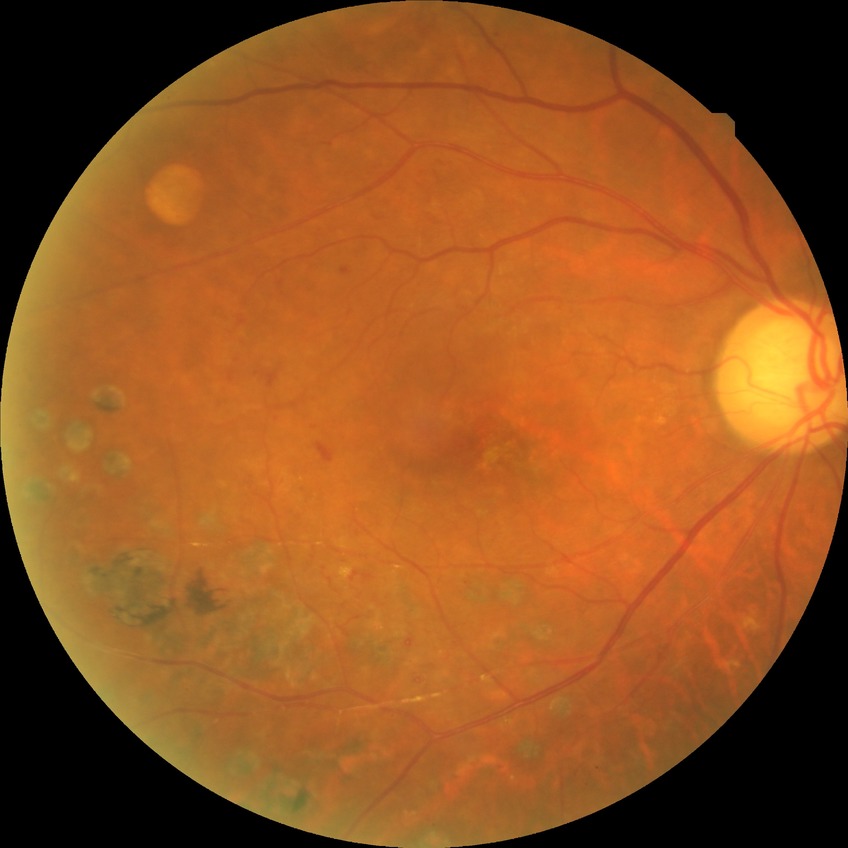 Davis grading: proliferative diabetic retinopathy.